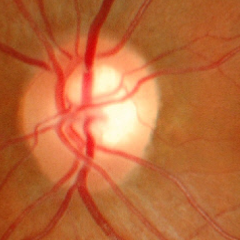 Optic disc appearance consistent with no glaucoma.